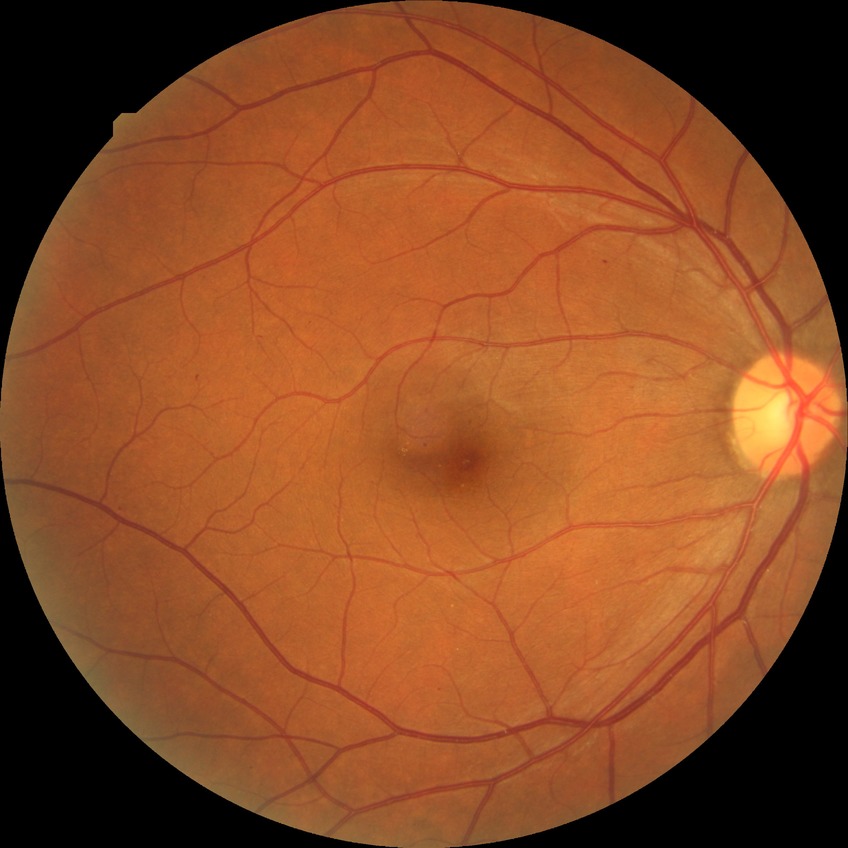

DR severity is SDR.